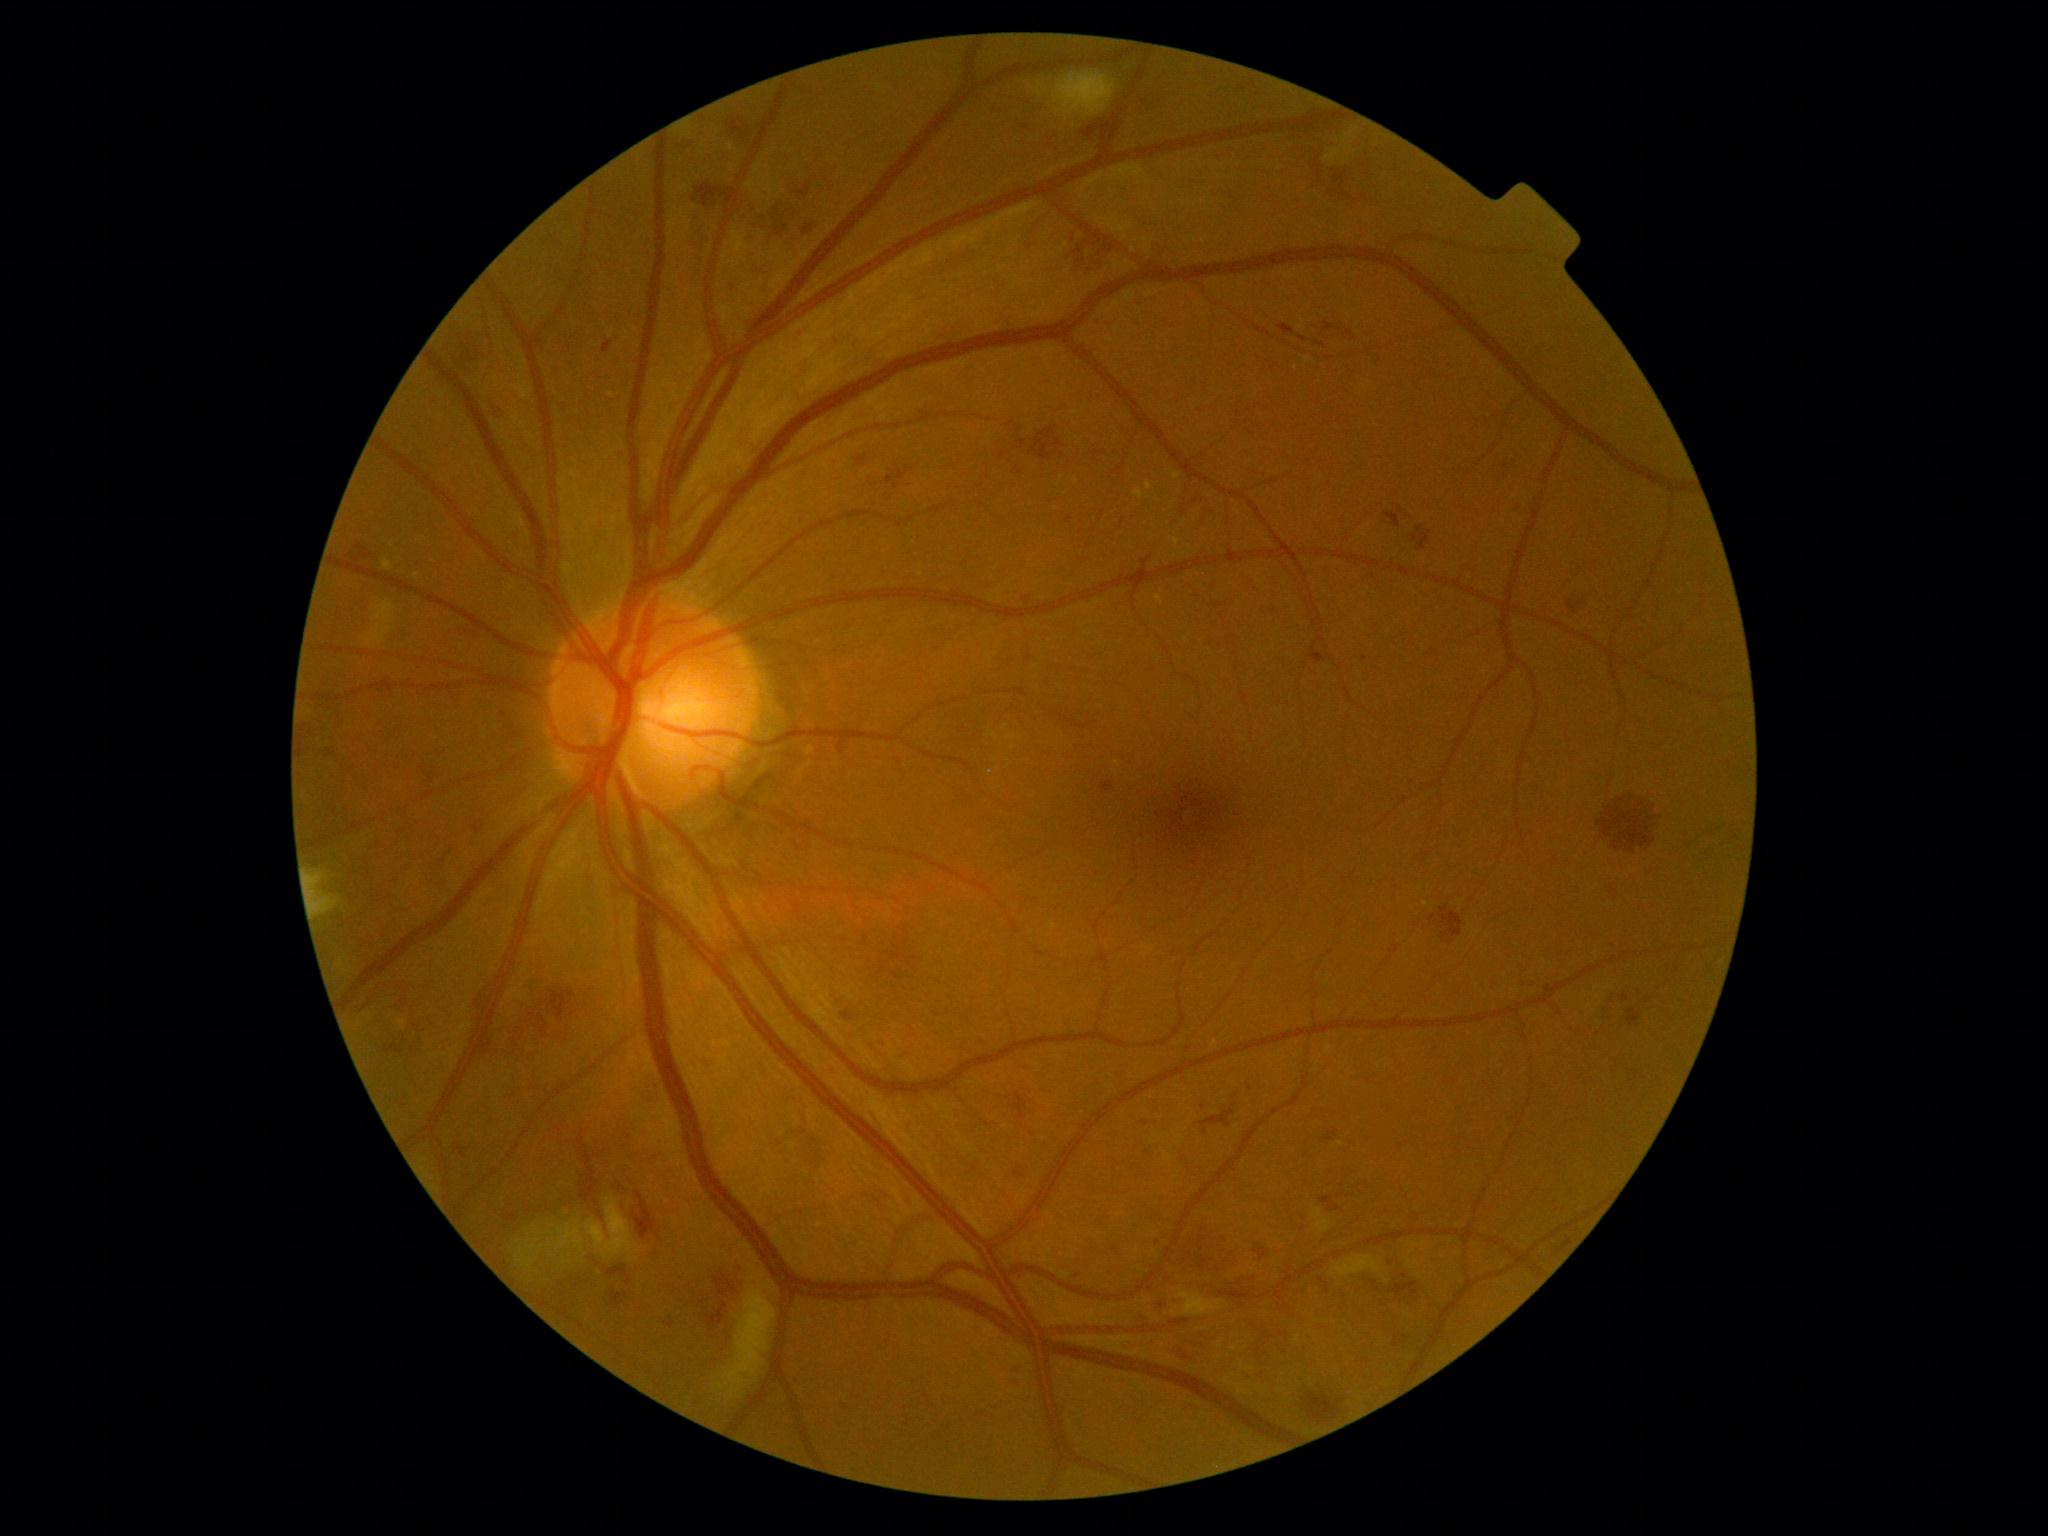
Retinopathy grade is 2 (moderate NPDR).